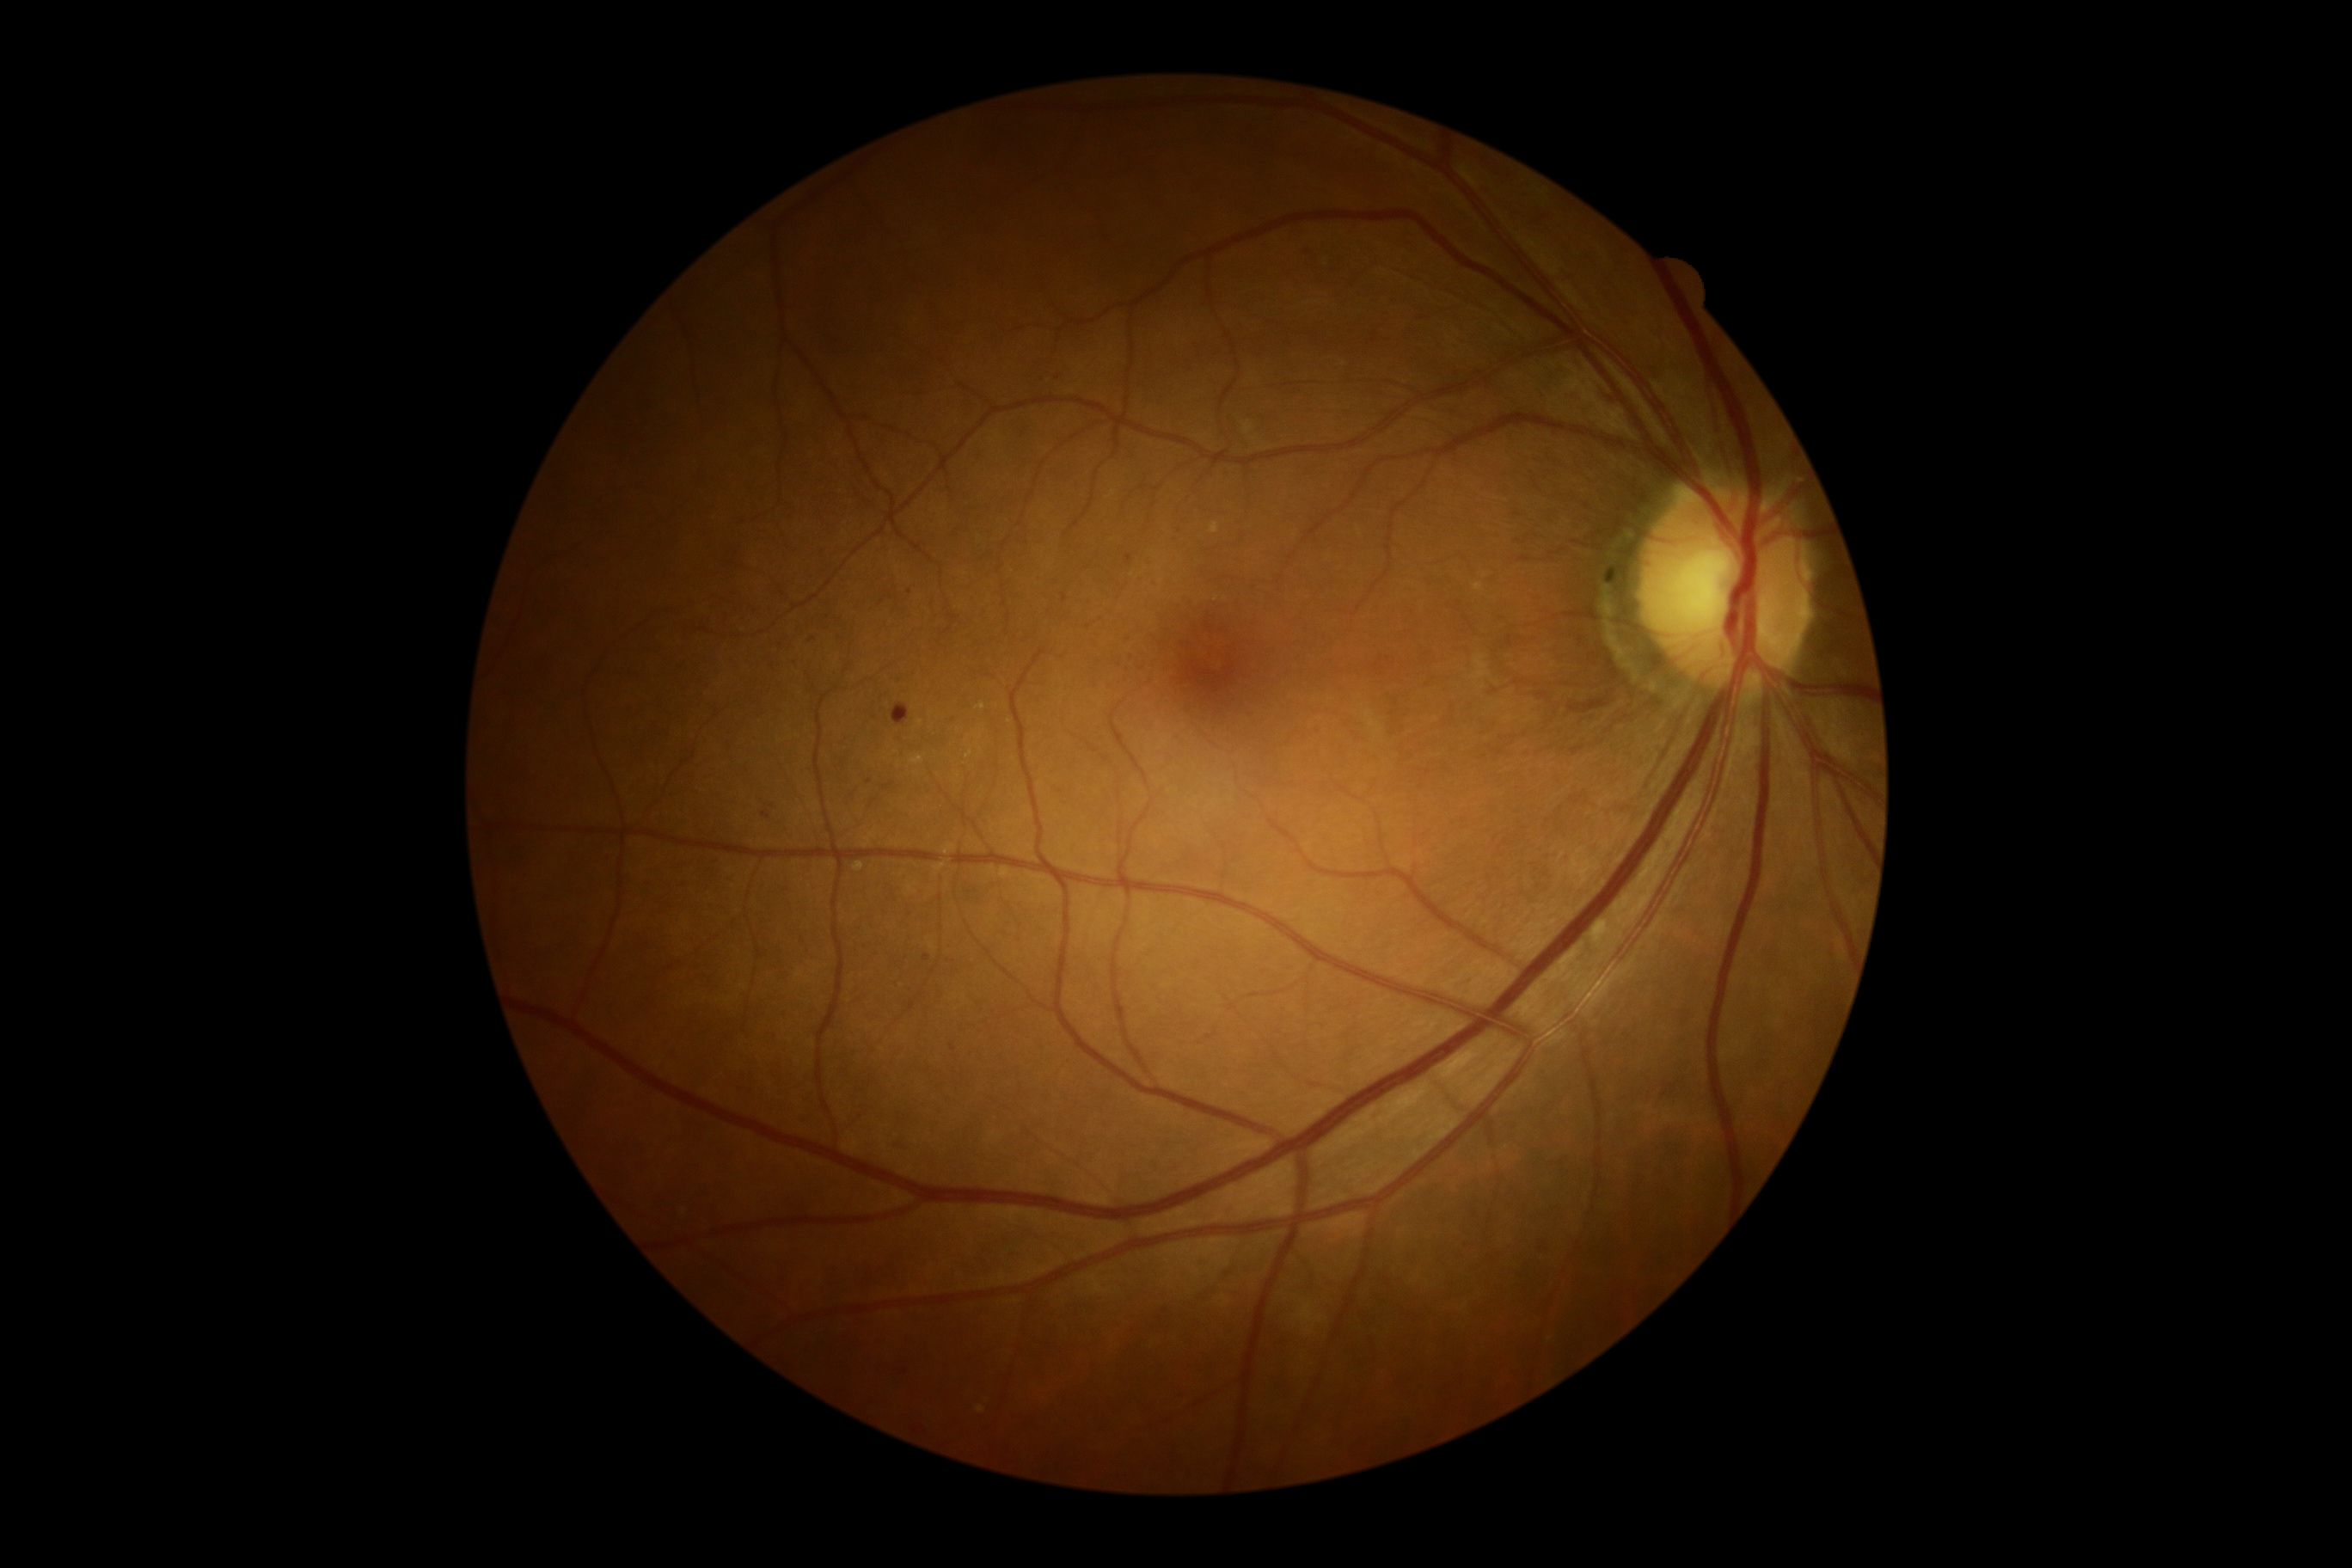
partial: true
dr_grade: 2
dr_grade_name: moderate NPDR
lesions:
  he:
    - bbox=(891, 704, 910, 725)
  se: []
  ma:
    - bbox=(1182, 642, 1192, 649)
    - bbox=(922, 955, 931, 962)
    - bbox=(1125, 554, 1134, 567)
    - bbox=(885, 592, 893, 599)
    - bbox=(646, 879, 652, 890)
    - bbox=(675, 879, 685, 890)
    - bbox=(809, 637, 818, 642)
    - bbox=(1062, 594, 1067, 603)
    - bbox=(761, 812, 769, 819)
  ma_small:
    - pt(905, 1371)
    - pt(1087, 601)
    - pt(1177, 542)
    - pt(882, 603)
    - pt(909, 592)
    - pt(772, 807)
    - pt(870, 782)
    - pt(952, 1048)
    - pt(1141, 580)
    - pt(828, 618)
    - pt(1151, 563)
  ex:
    - bbox=(910, 756, 924, 764)
    - bbox=(854, 862, 864, 873)
    - bbox=(1211, 522, 1218, 534)
    - bbox=(976, 1407, 986, 1414)
    - bbox=(976, 704, 986, 711)
    - bbox=(1244, 422, 1254, 434)
    - bbox=(1473, 584, 1483, 592)
  ex_small:
    - pt(1010, 721)
    - pt(921, 723)
    - pt(968, 755)